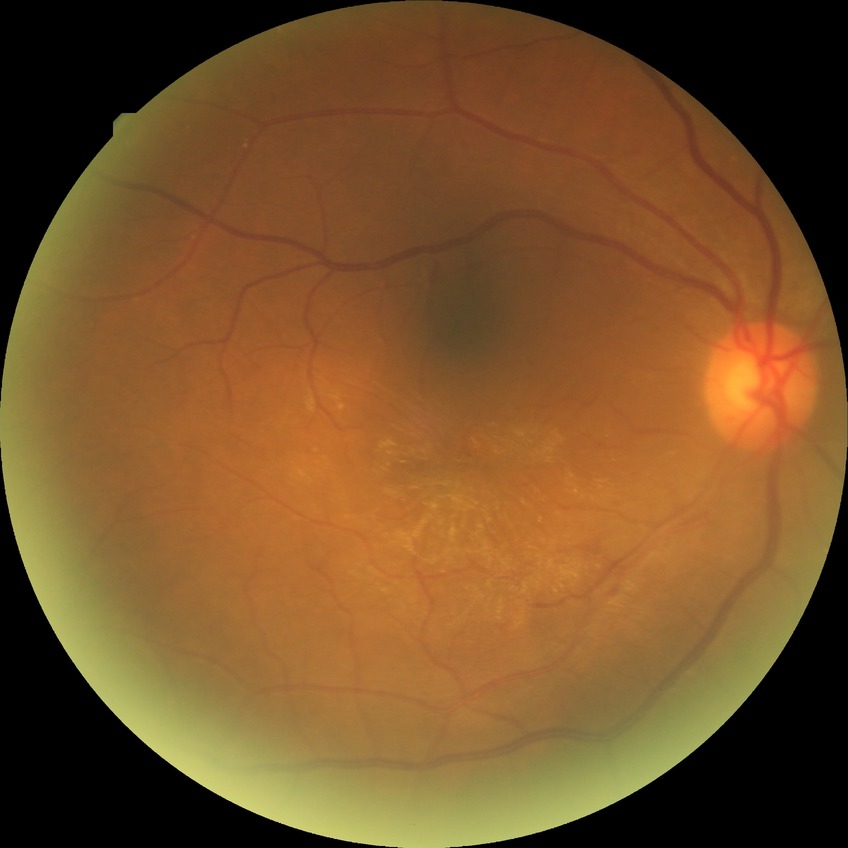
retinopathy stage = no diabetic retinopathy.